1240 x 1240 pixels · wide-field fundus photograph of an infant: 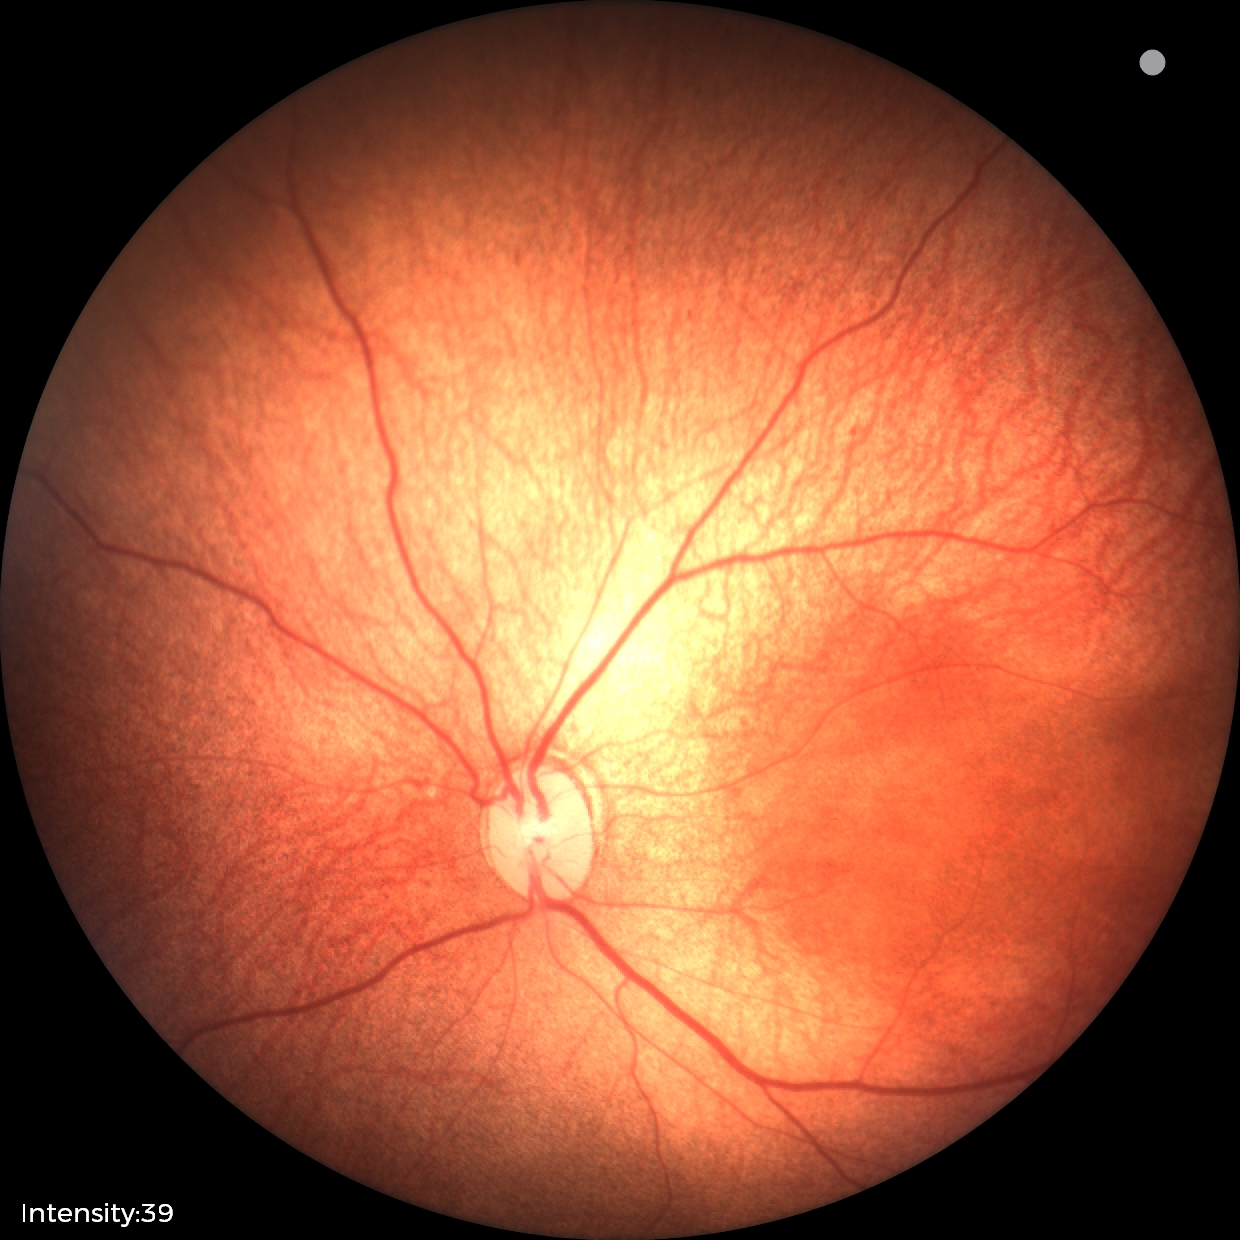 Plus form = absent — posterior pole vessels without abnormal dilation or tortuosity | assessment = status post retinopathy of prematurity.